Graded on the modified Davis scale · posterior pole color fundus photograph.
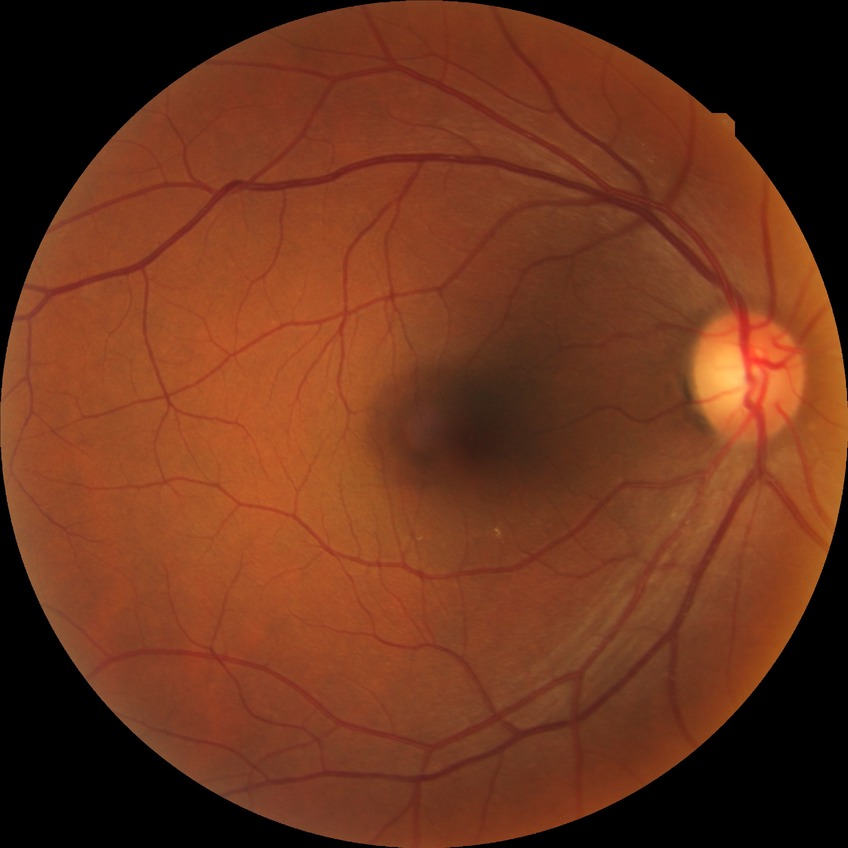

Davis grading: no diabetic retinopathy.